Davis DR grading, 45 degree fundus photograph, image size 848x848
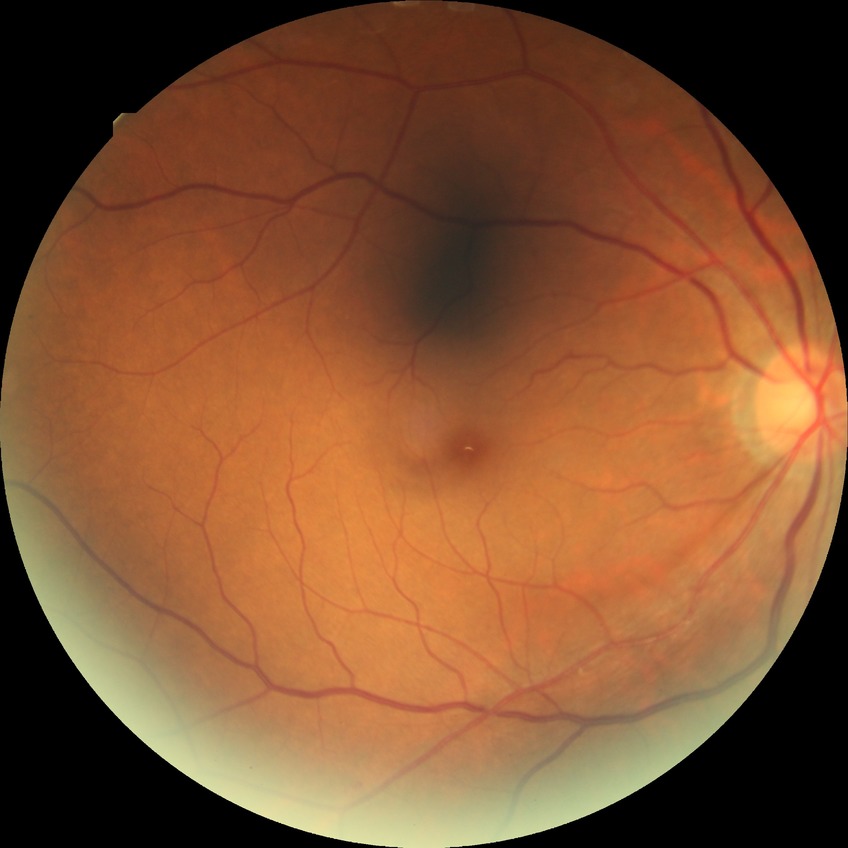
Diabetic retinopathy (DR): no diabetic retinopathy (NDR).